Pediatric retinal photograph (wide-field); camera: Natus RetCam Envision (130° FOV).
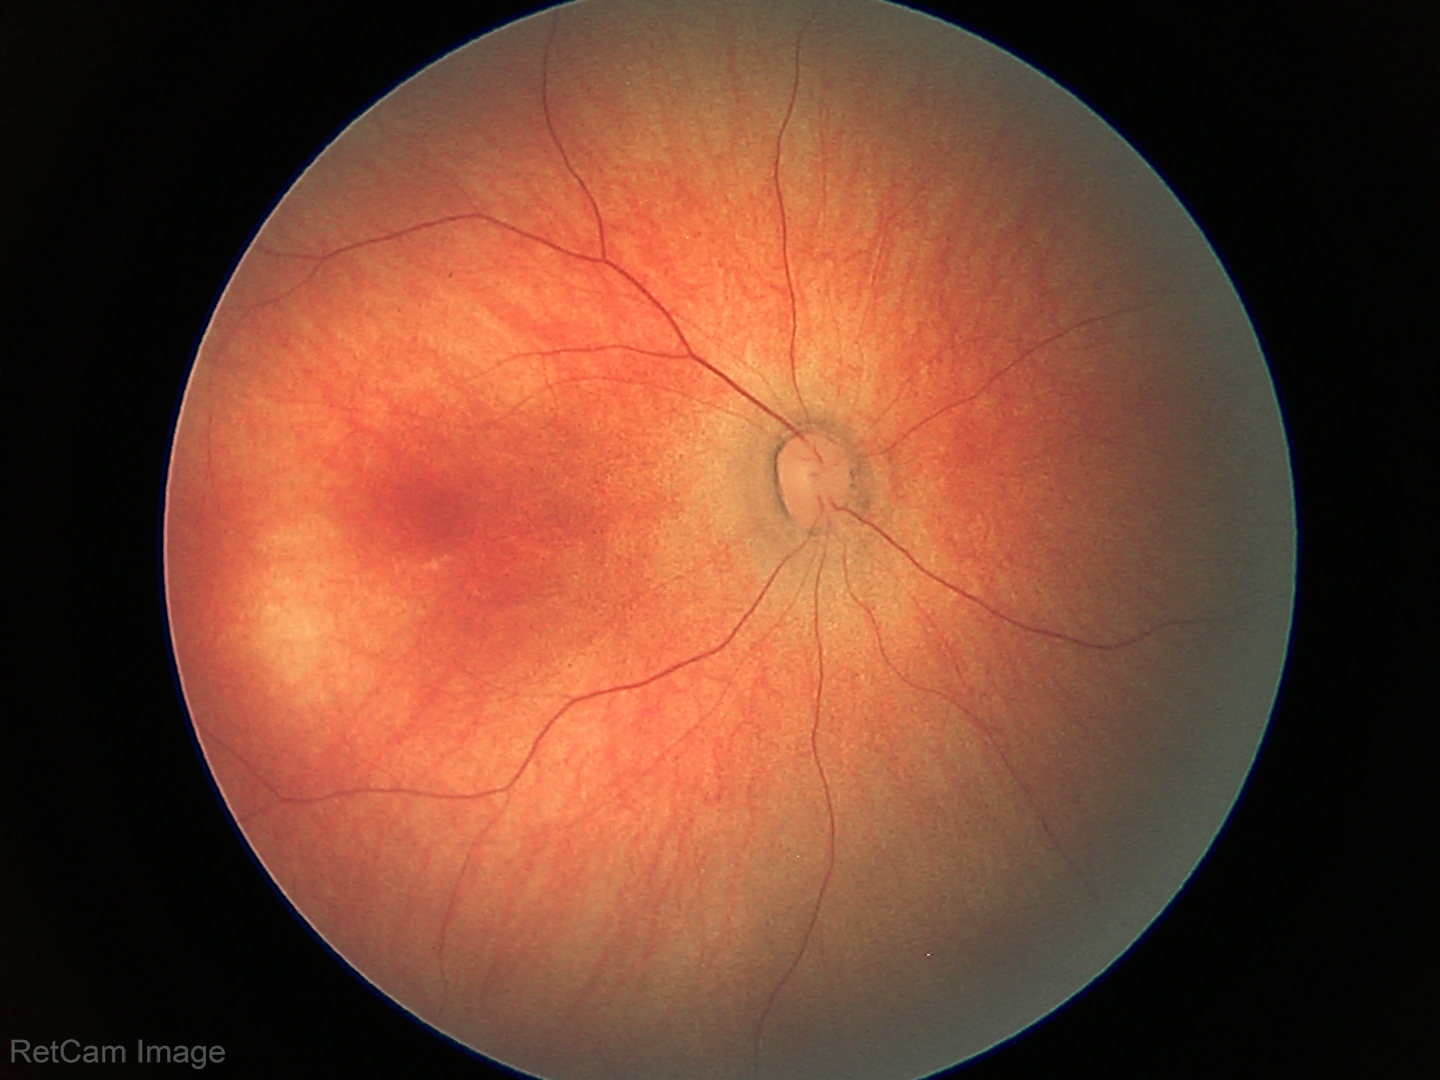

No retinal pathology identified on screening.